Ultra-widefield (UWF) fundus image
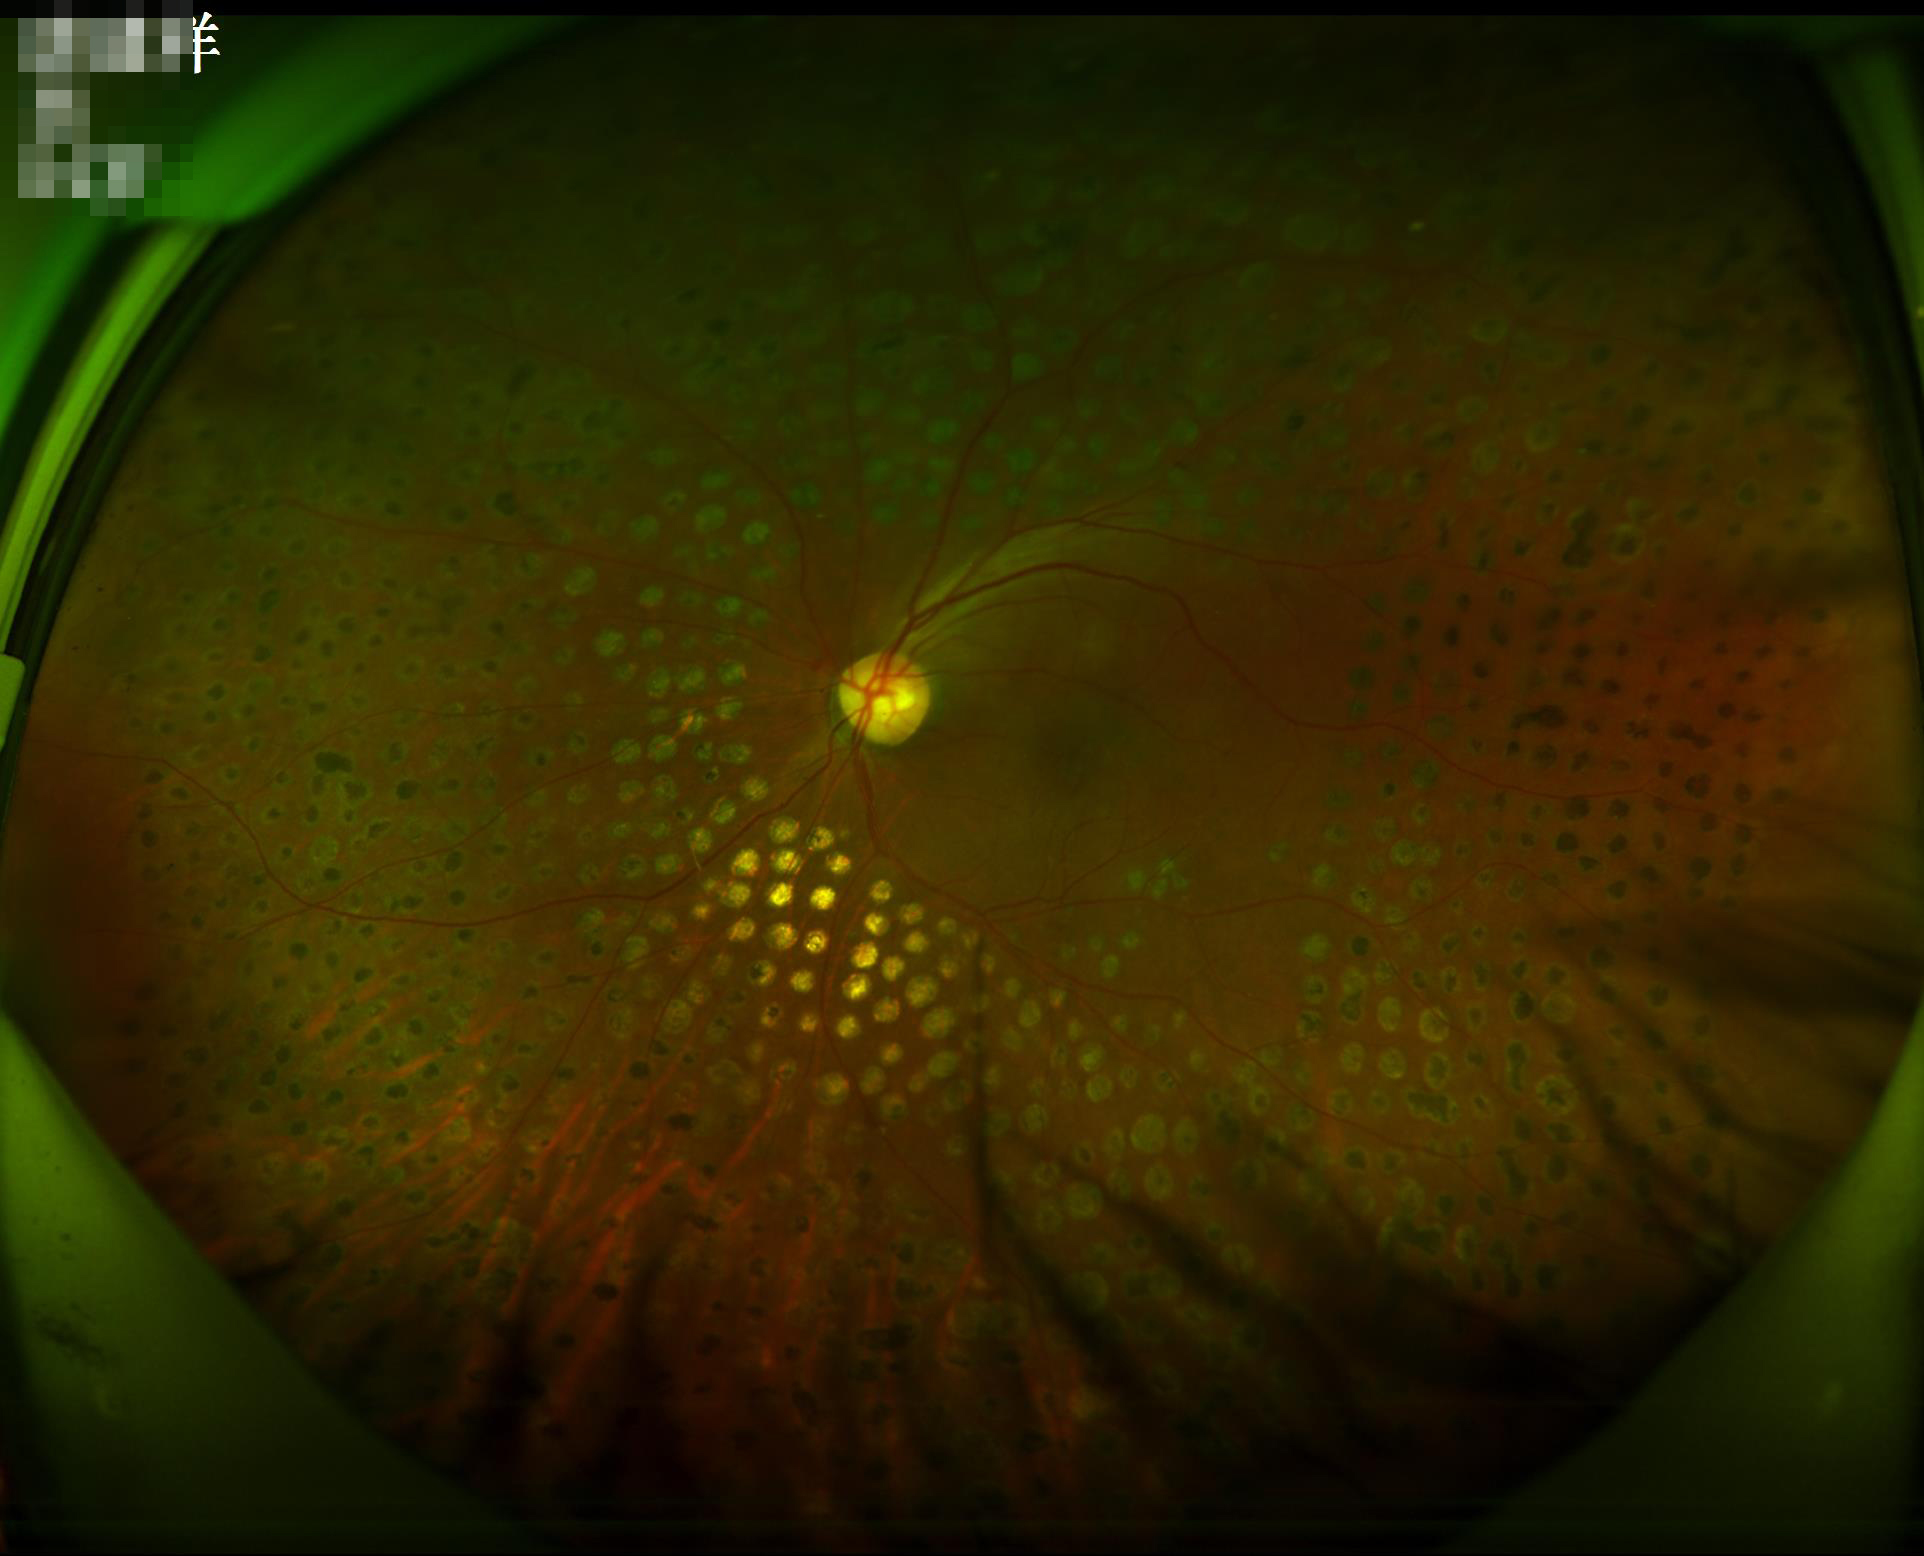

Illumination/color = suboptimal
Overall quality = acceptable